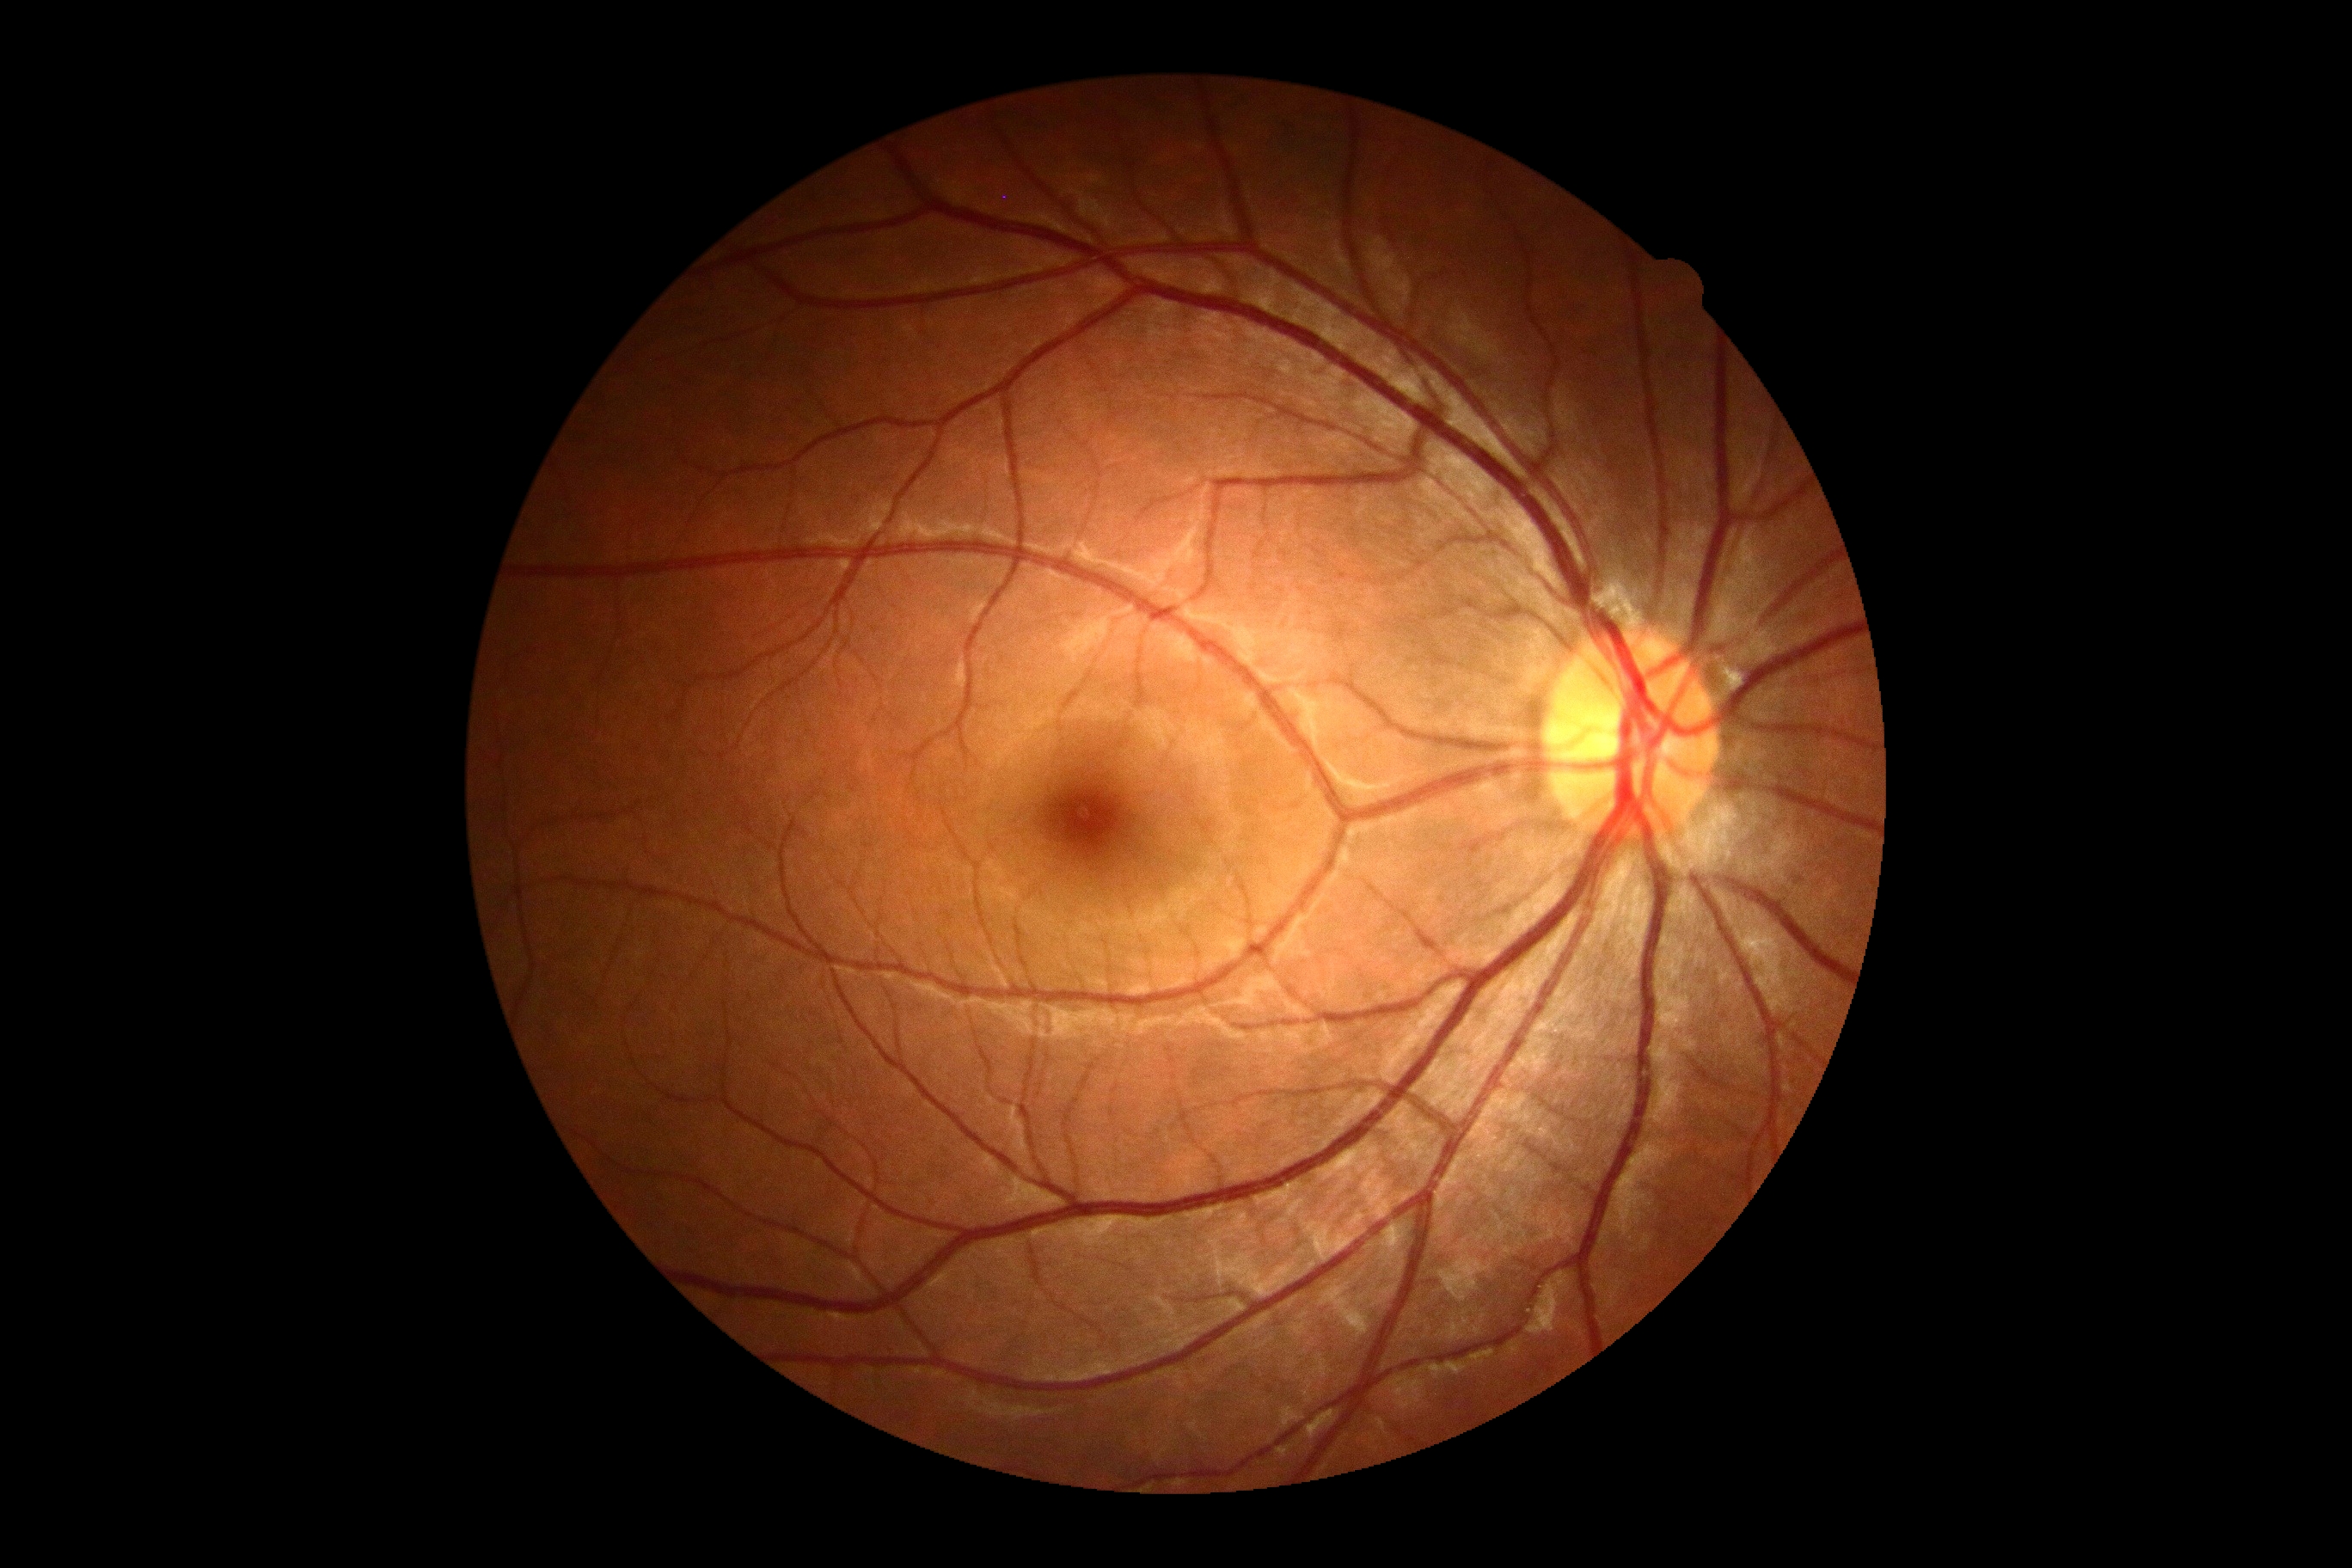

DR impression = no apparent DR, diabetic retinopathy grade = no apparent retinopathy (0).